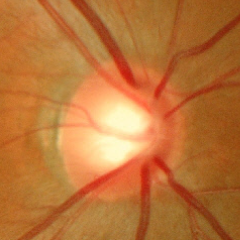
Impression = no glaucomatous changes.